Color fundus image. FOV: 45 degrees. Image size 2352x1568:
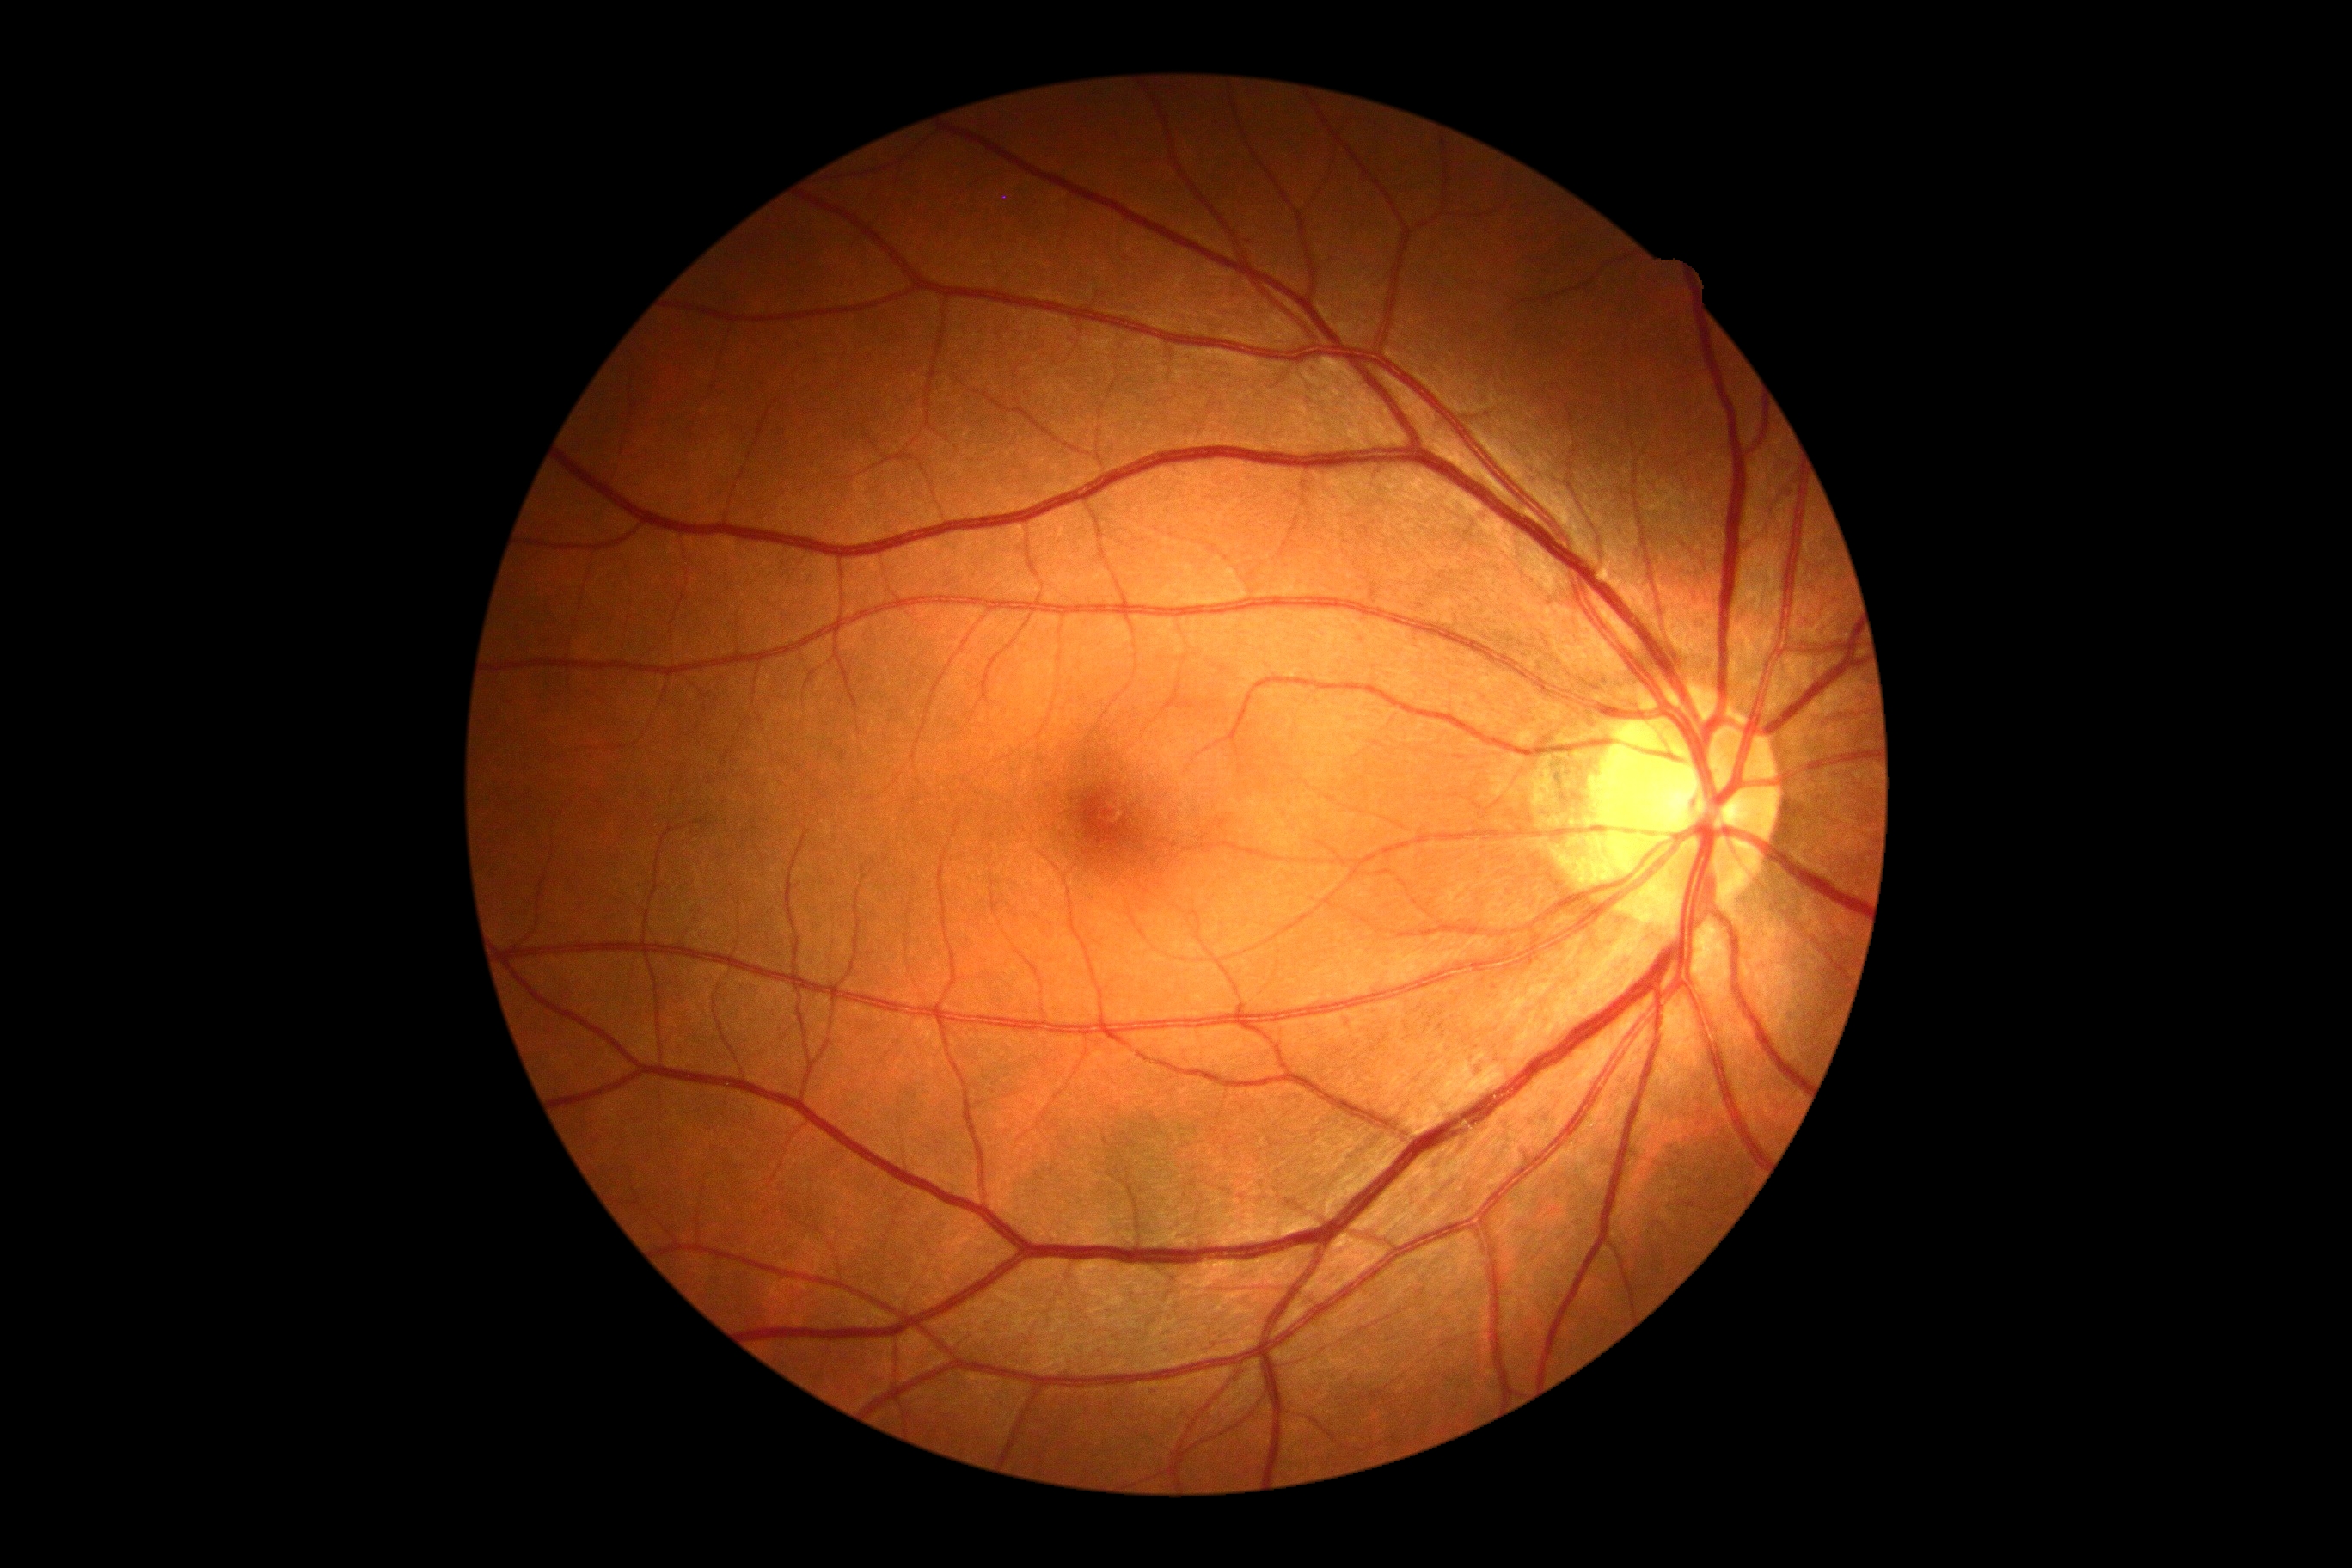

DR impression = no signs of DR | DR grade = 0.